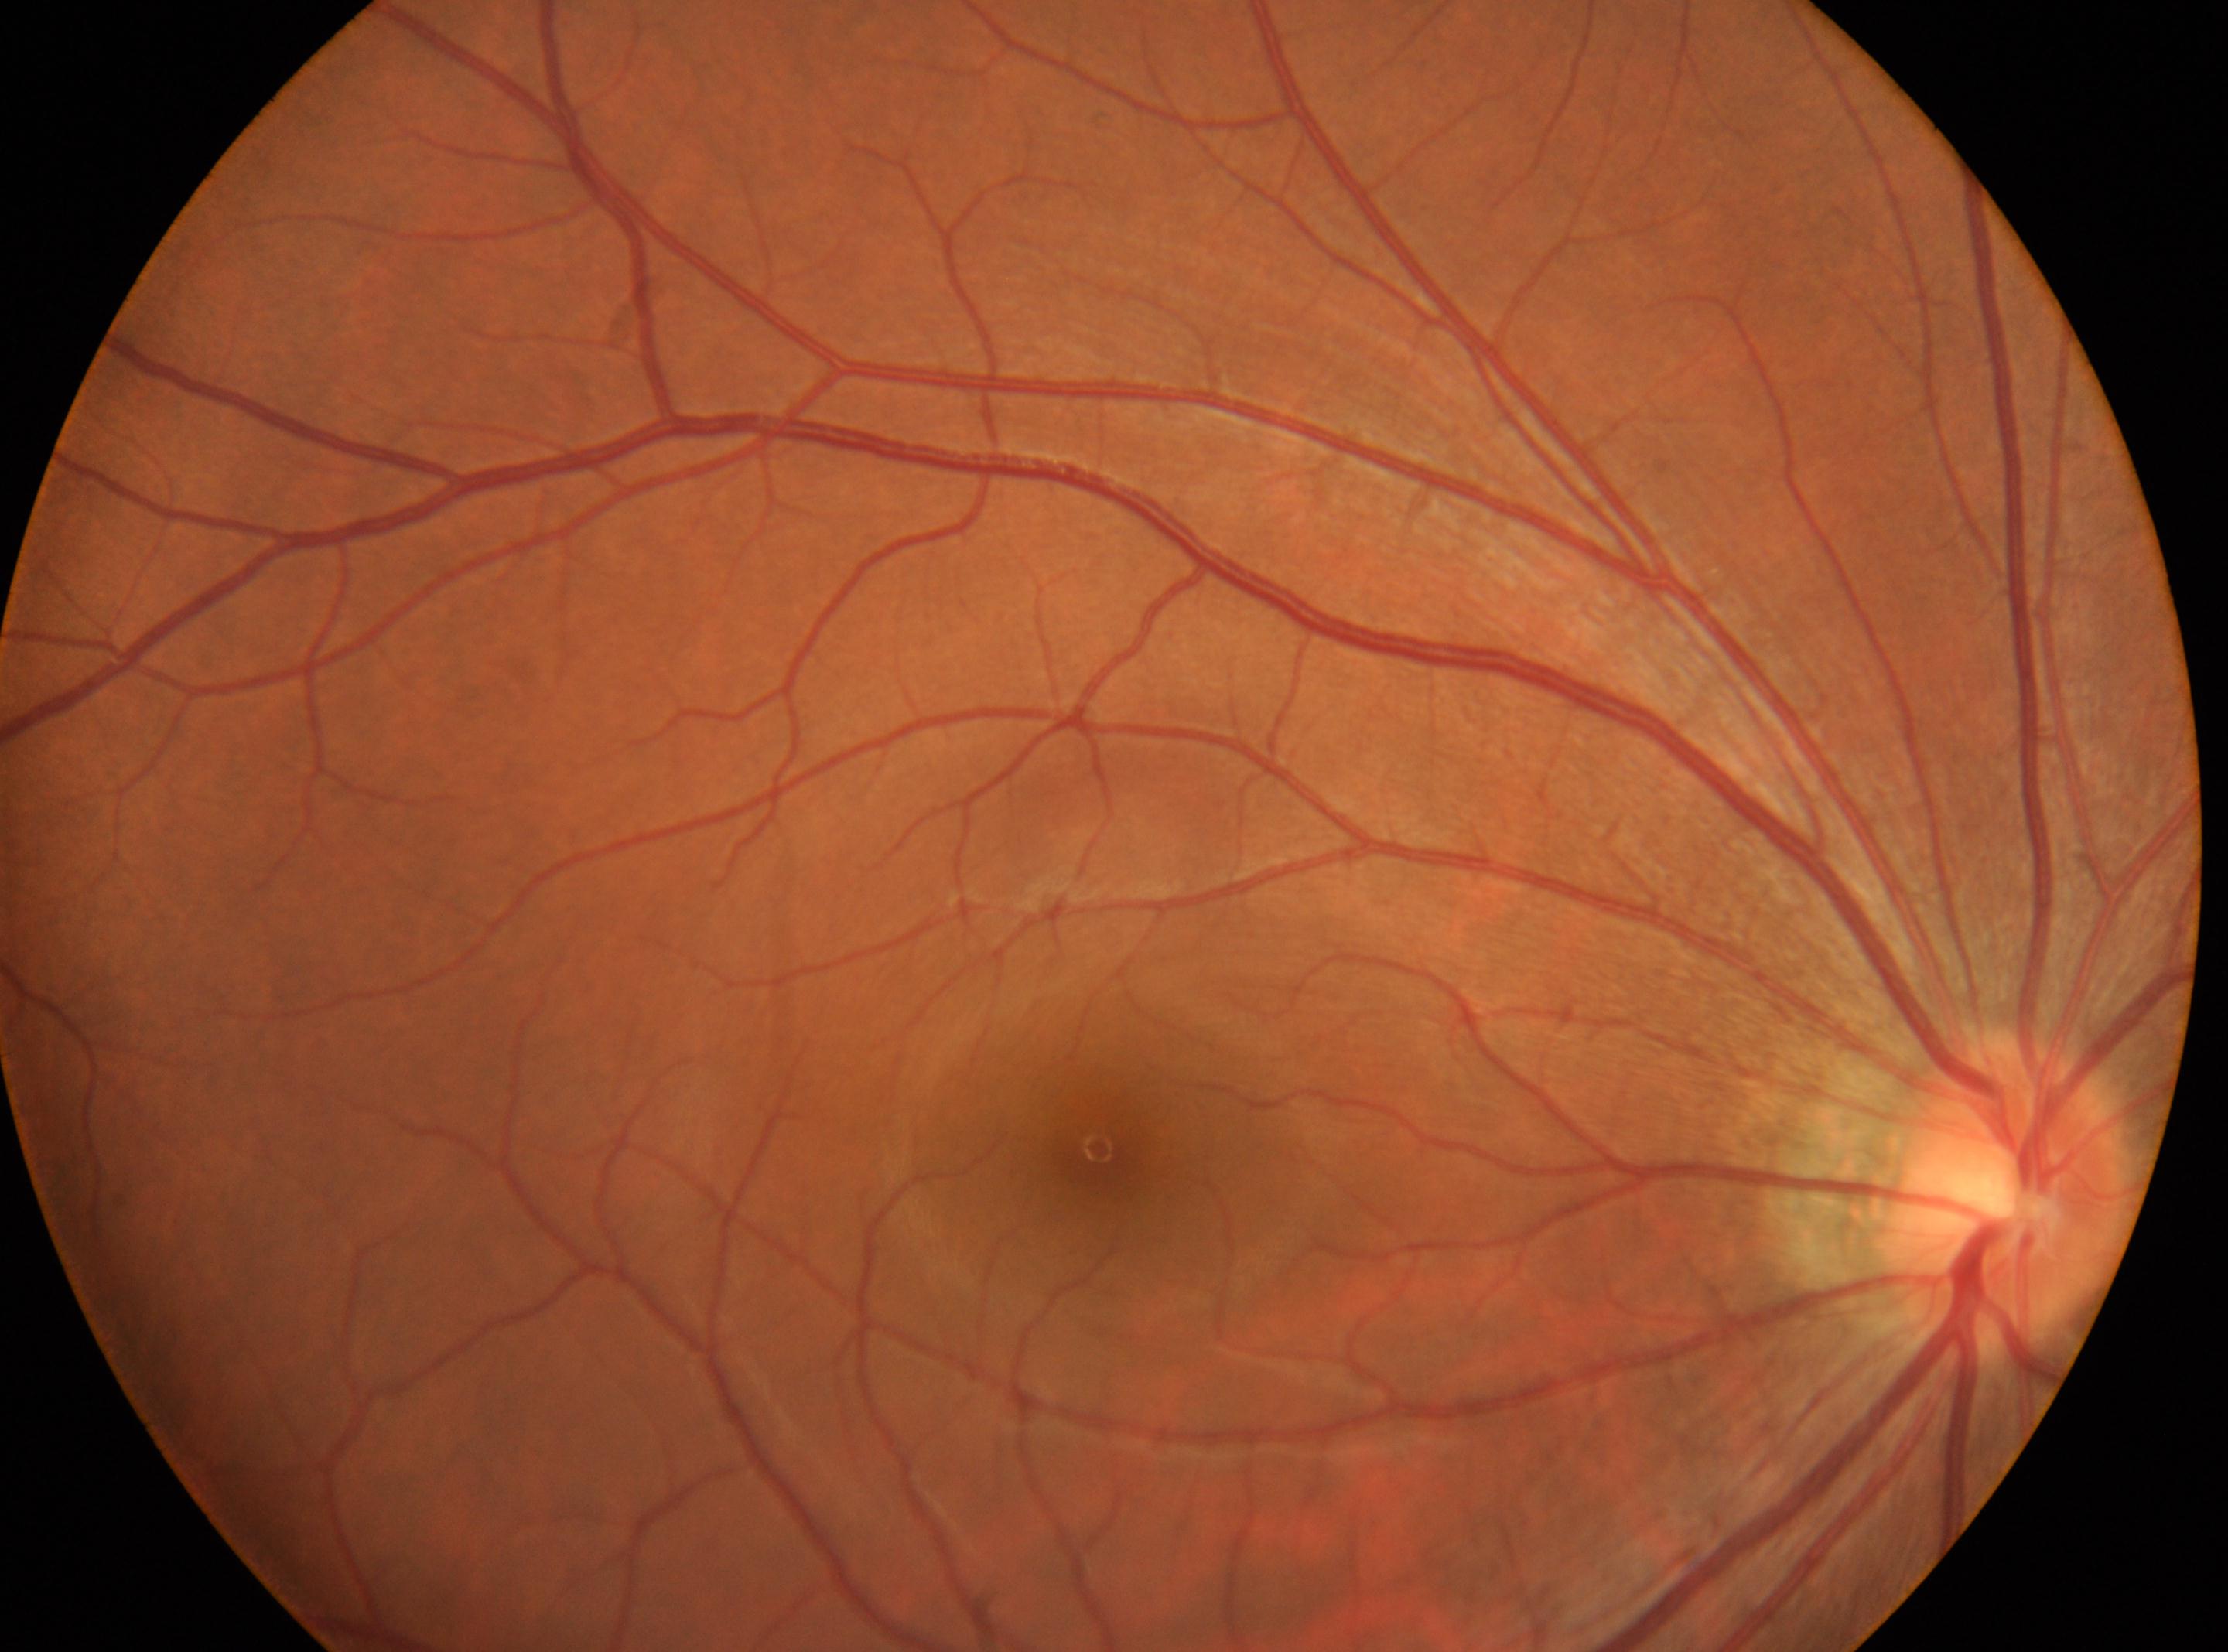 fovea center = 1099px, 1149px
diabetic retinopathy (DR) = 0
laterality = the right eye
optic disc = 2004px, 1196px